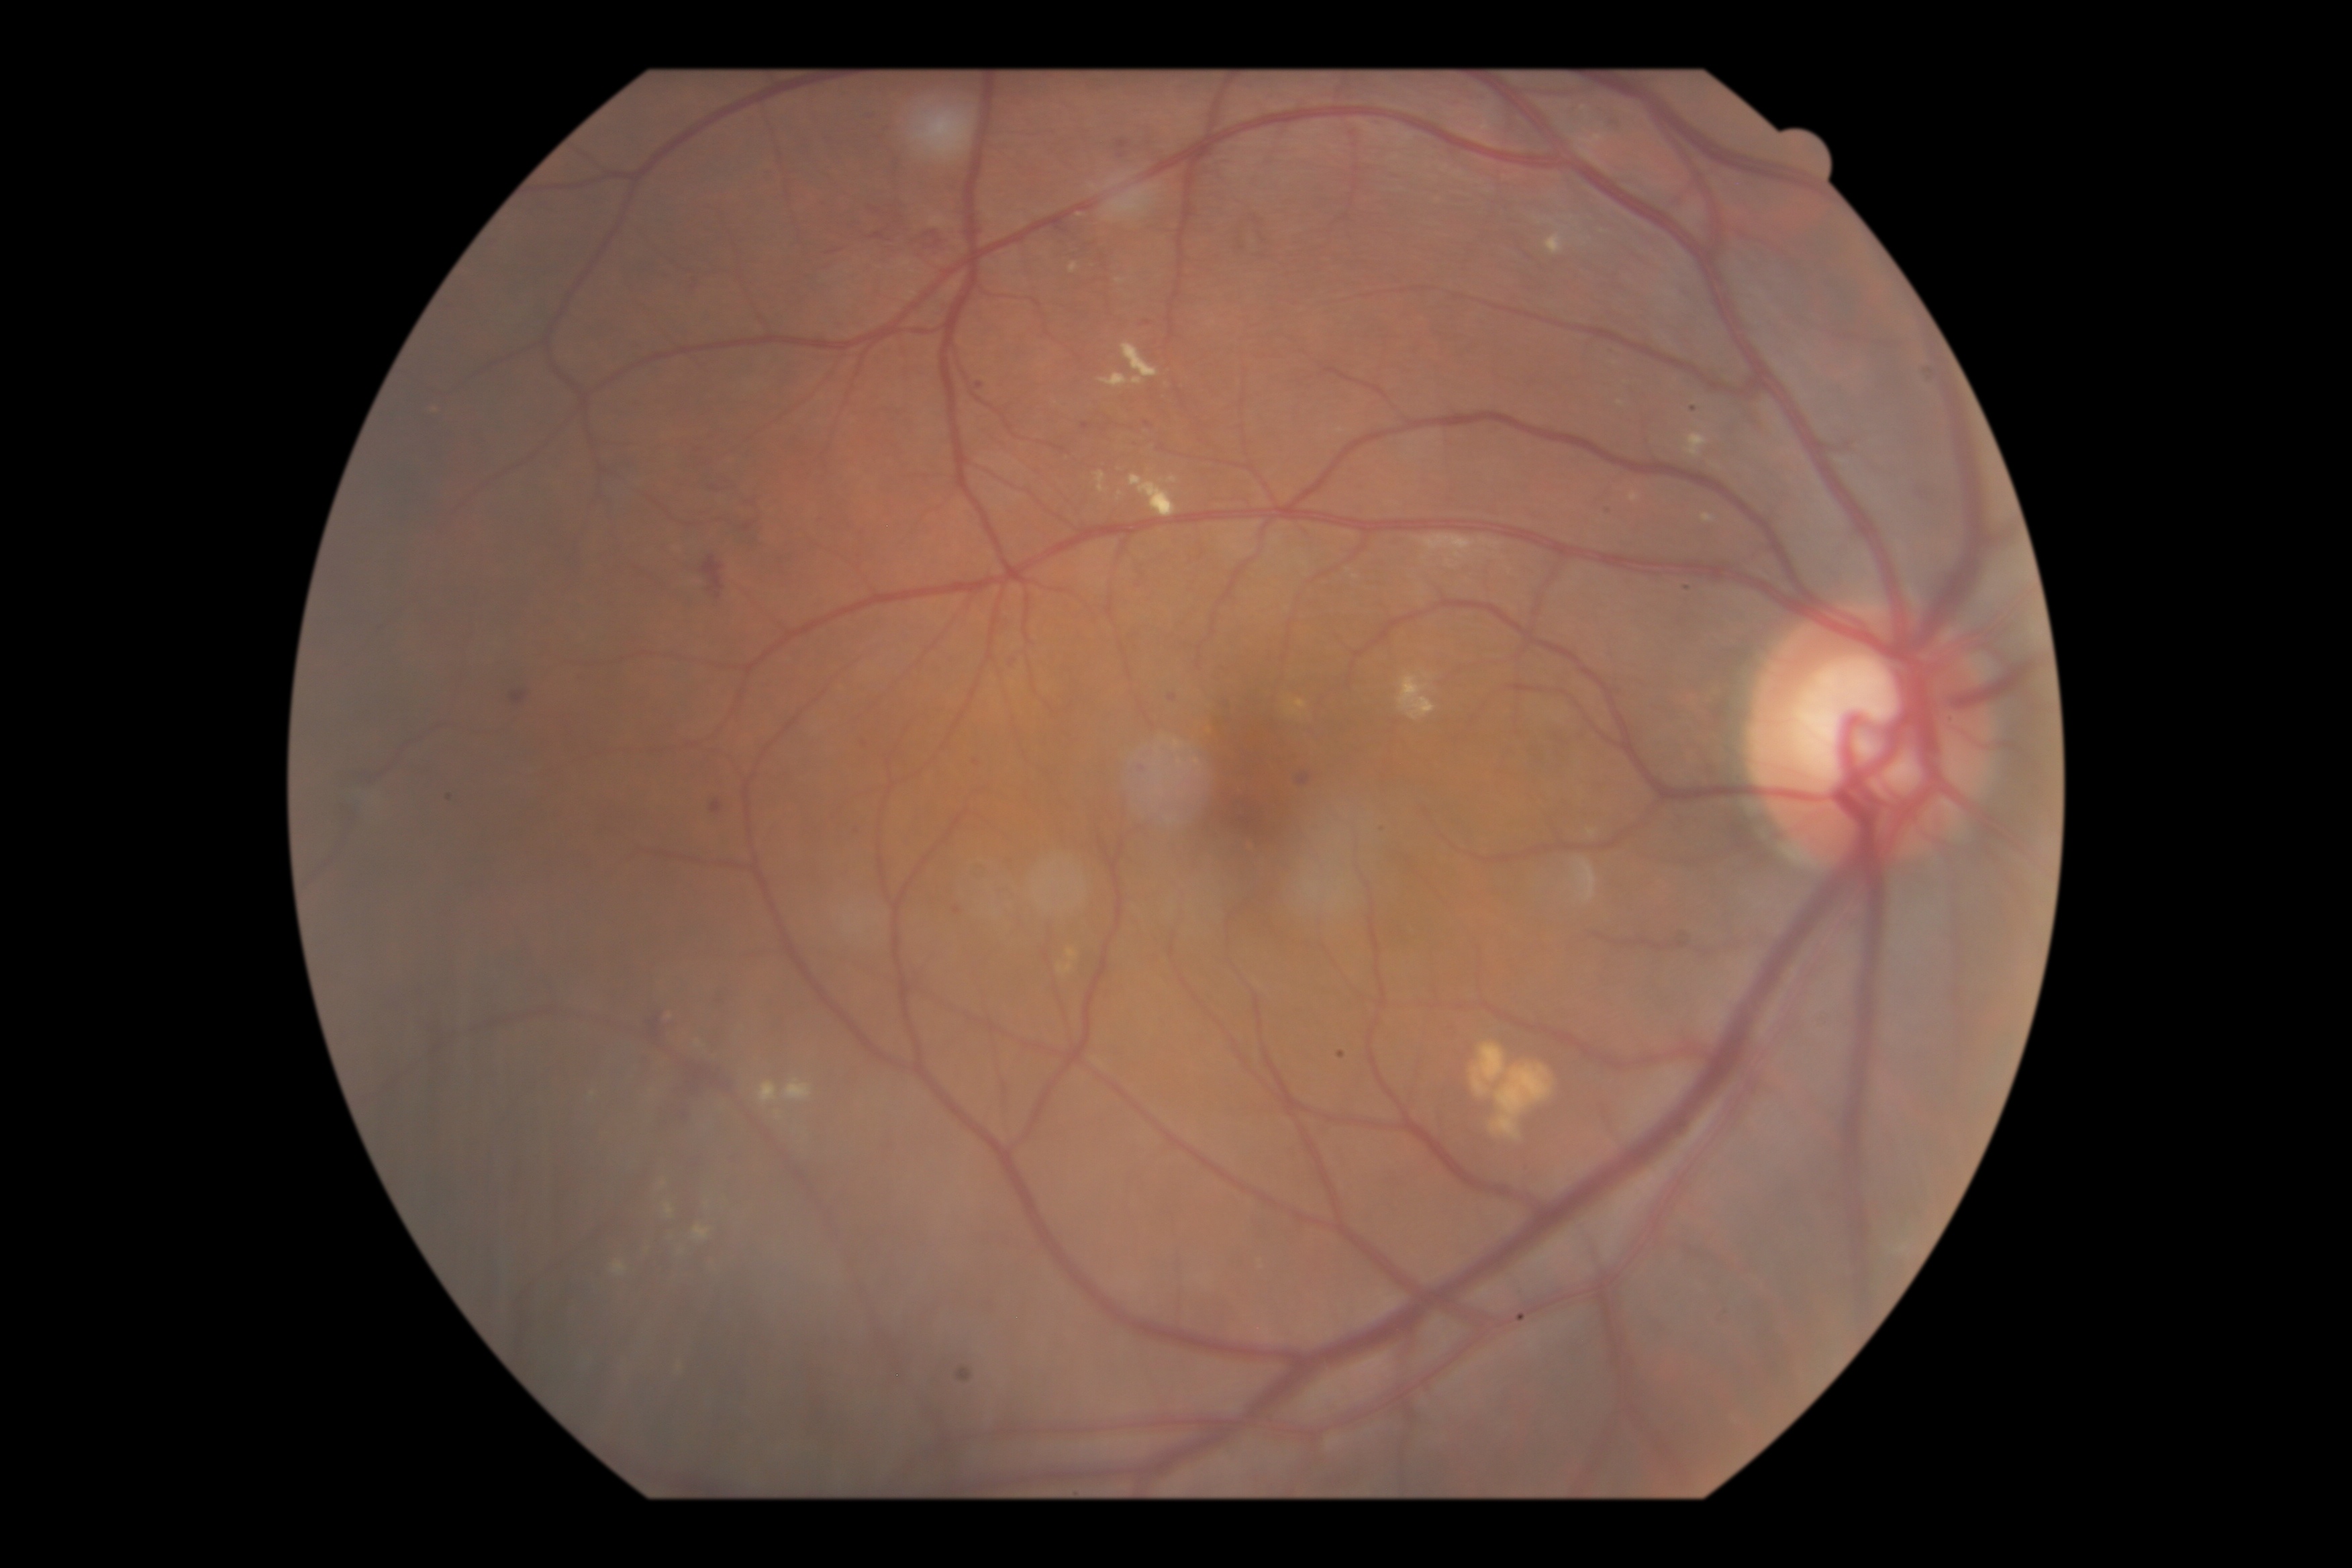 DR stage: grade 2.